848 x 848 pixels. Color fundus photograph. NIDEK AFC-230 fundus camera. 45° field of view
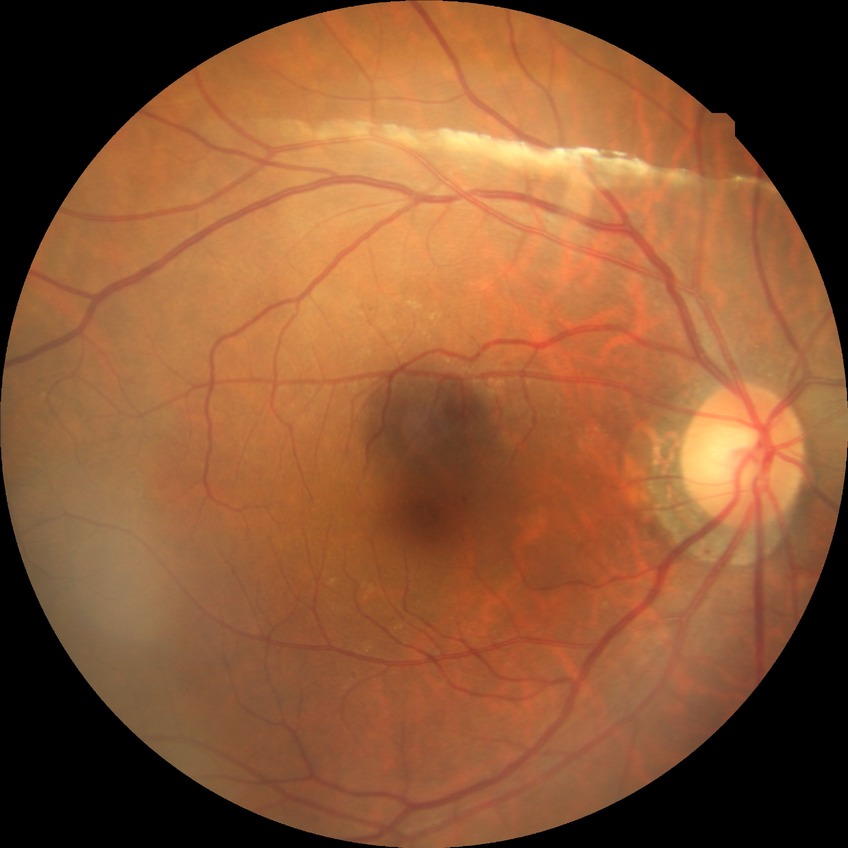 modified Davis classification@no diabetic retinopathy.